Captured with the Clarity RetCam 3 (130° field of view) · wide-field fundus photograph of an infant:
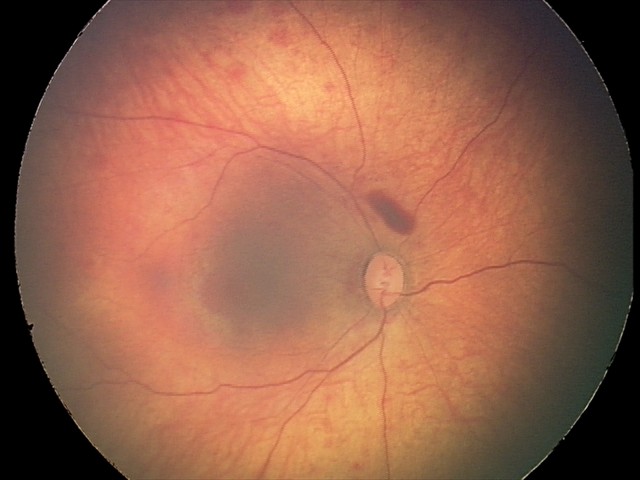

Series diagnosed as retinal hemorrhages.